Mydriatic acquisition; fundus image cropped to the optic disc: 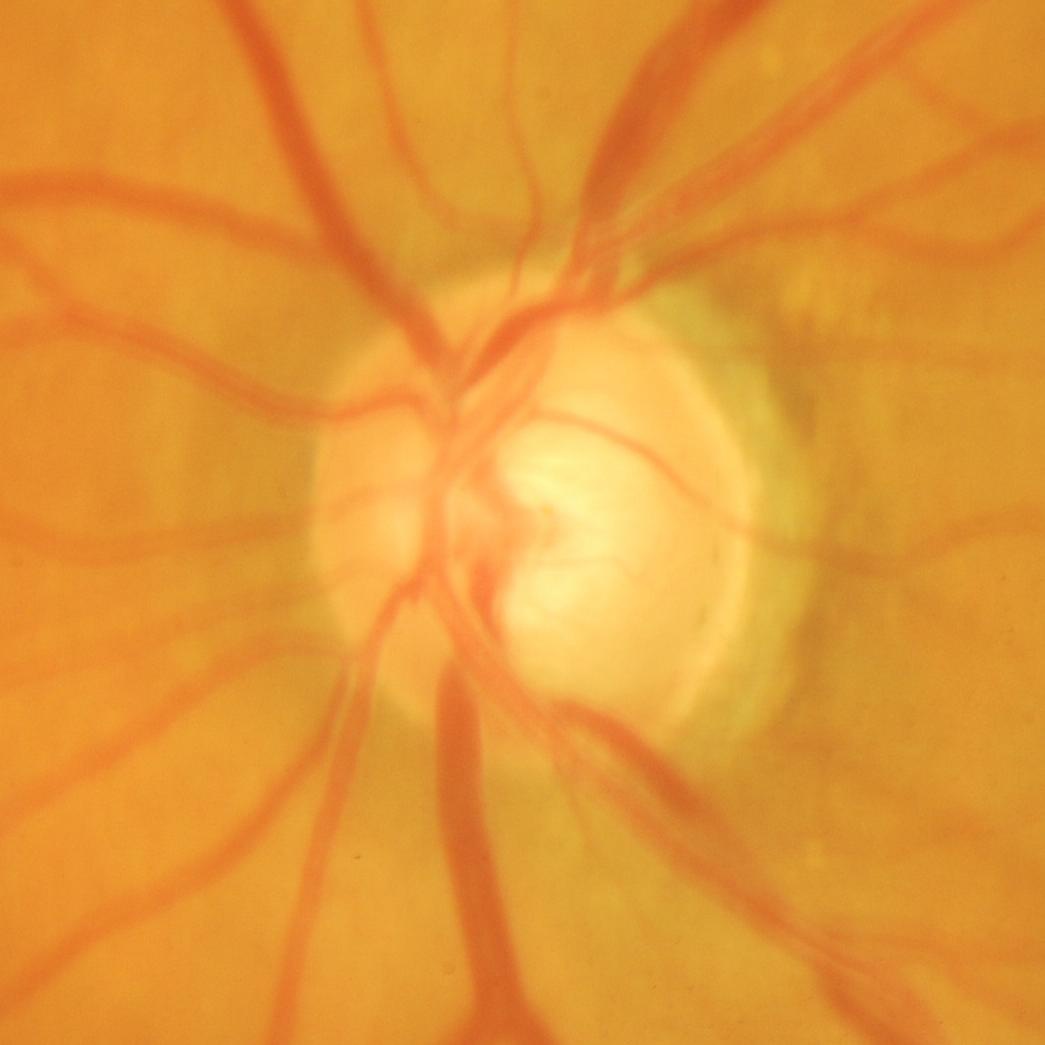
Impression: glaucoma.